DR severity per modified Davis staging. 45° field of view — 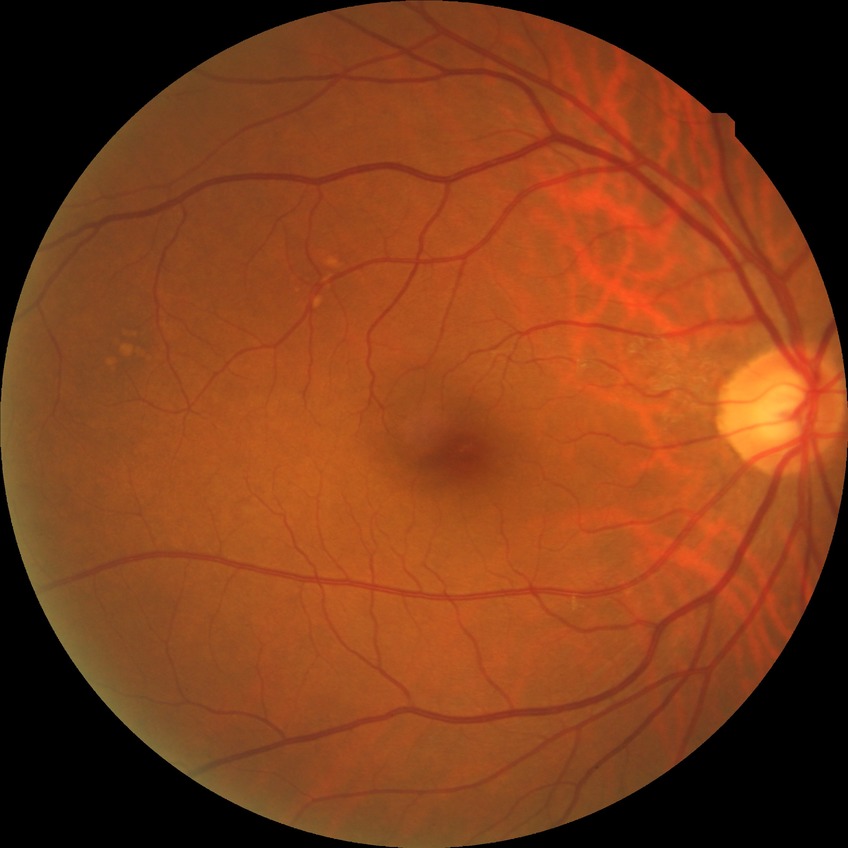

Diabetic retinopathy (DR) is NDR (no diabetic retinopathy).